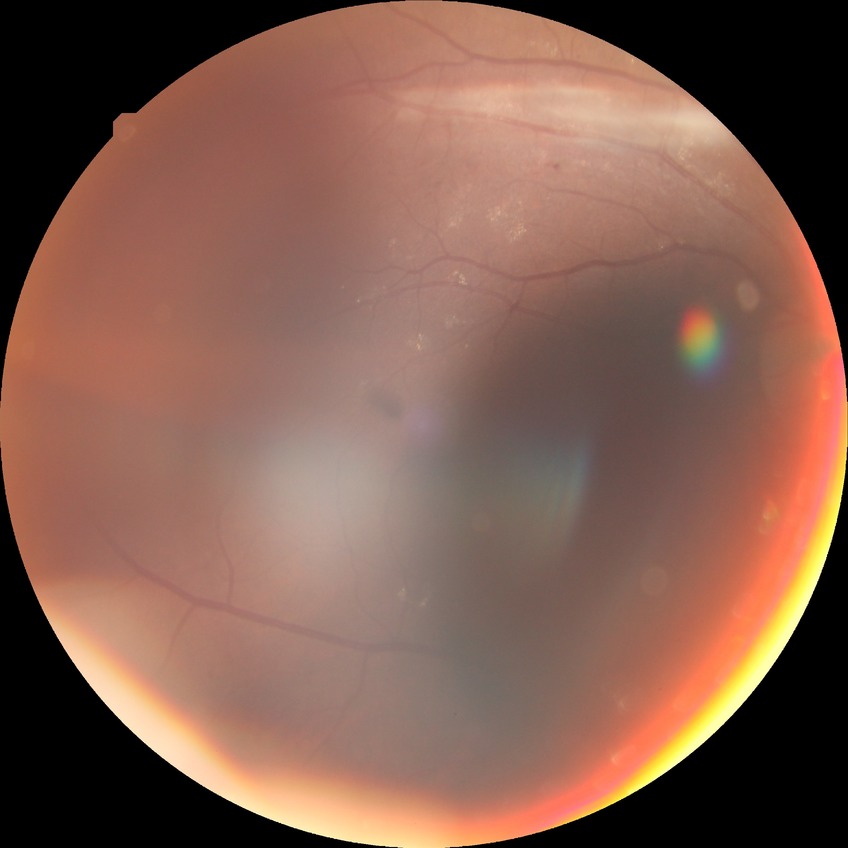 Diabetic retinopathy stage is simple diabetic retinopathy.